FOV: 45 degrees. 2212x1659. Retinal fundus photograph:
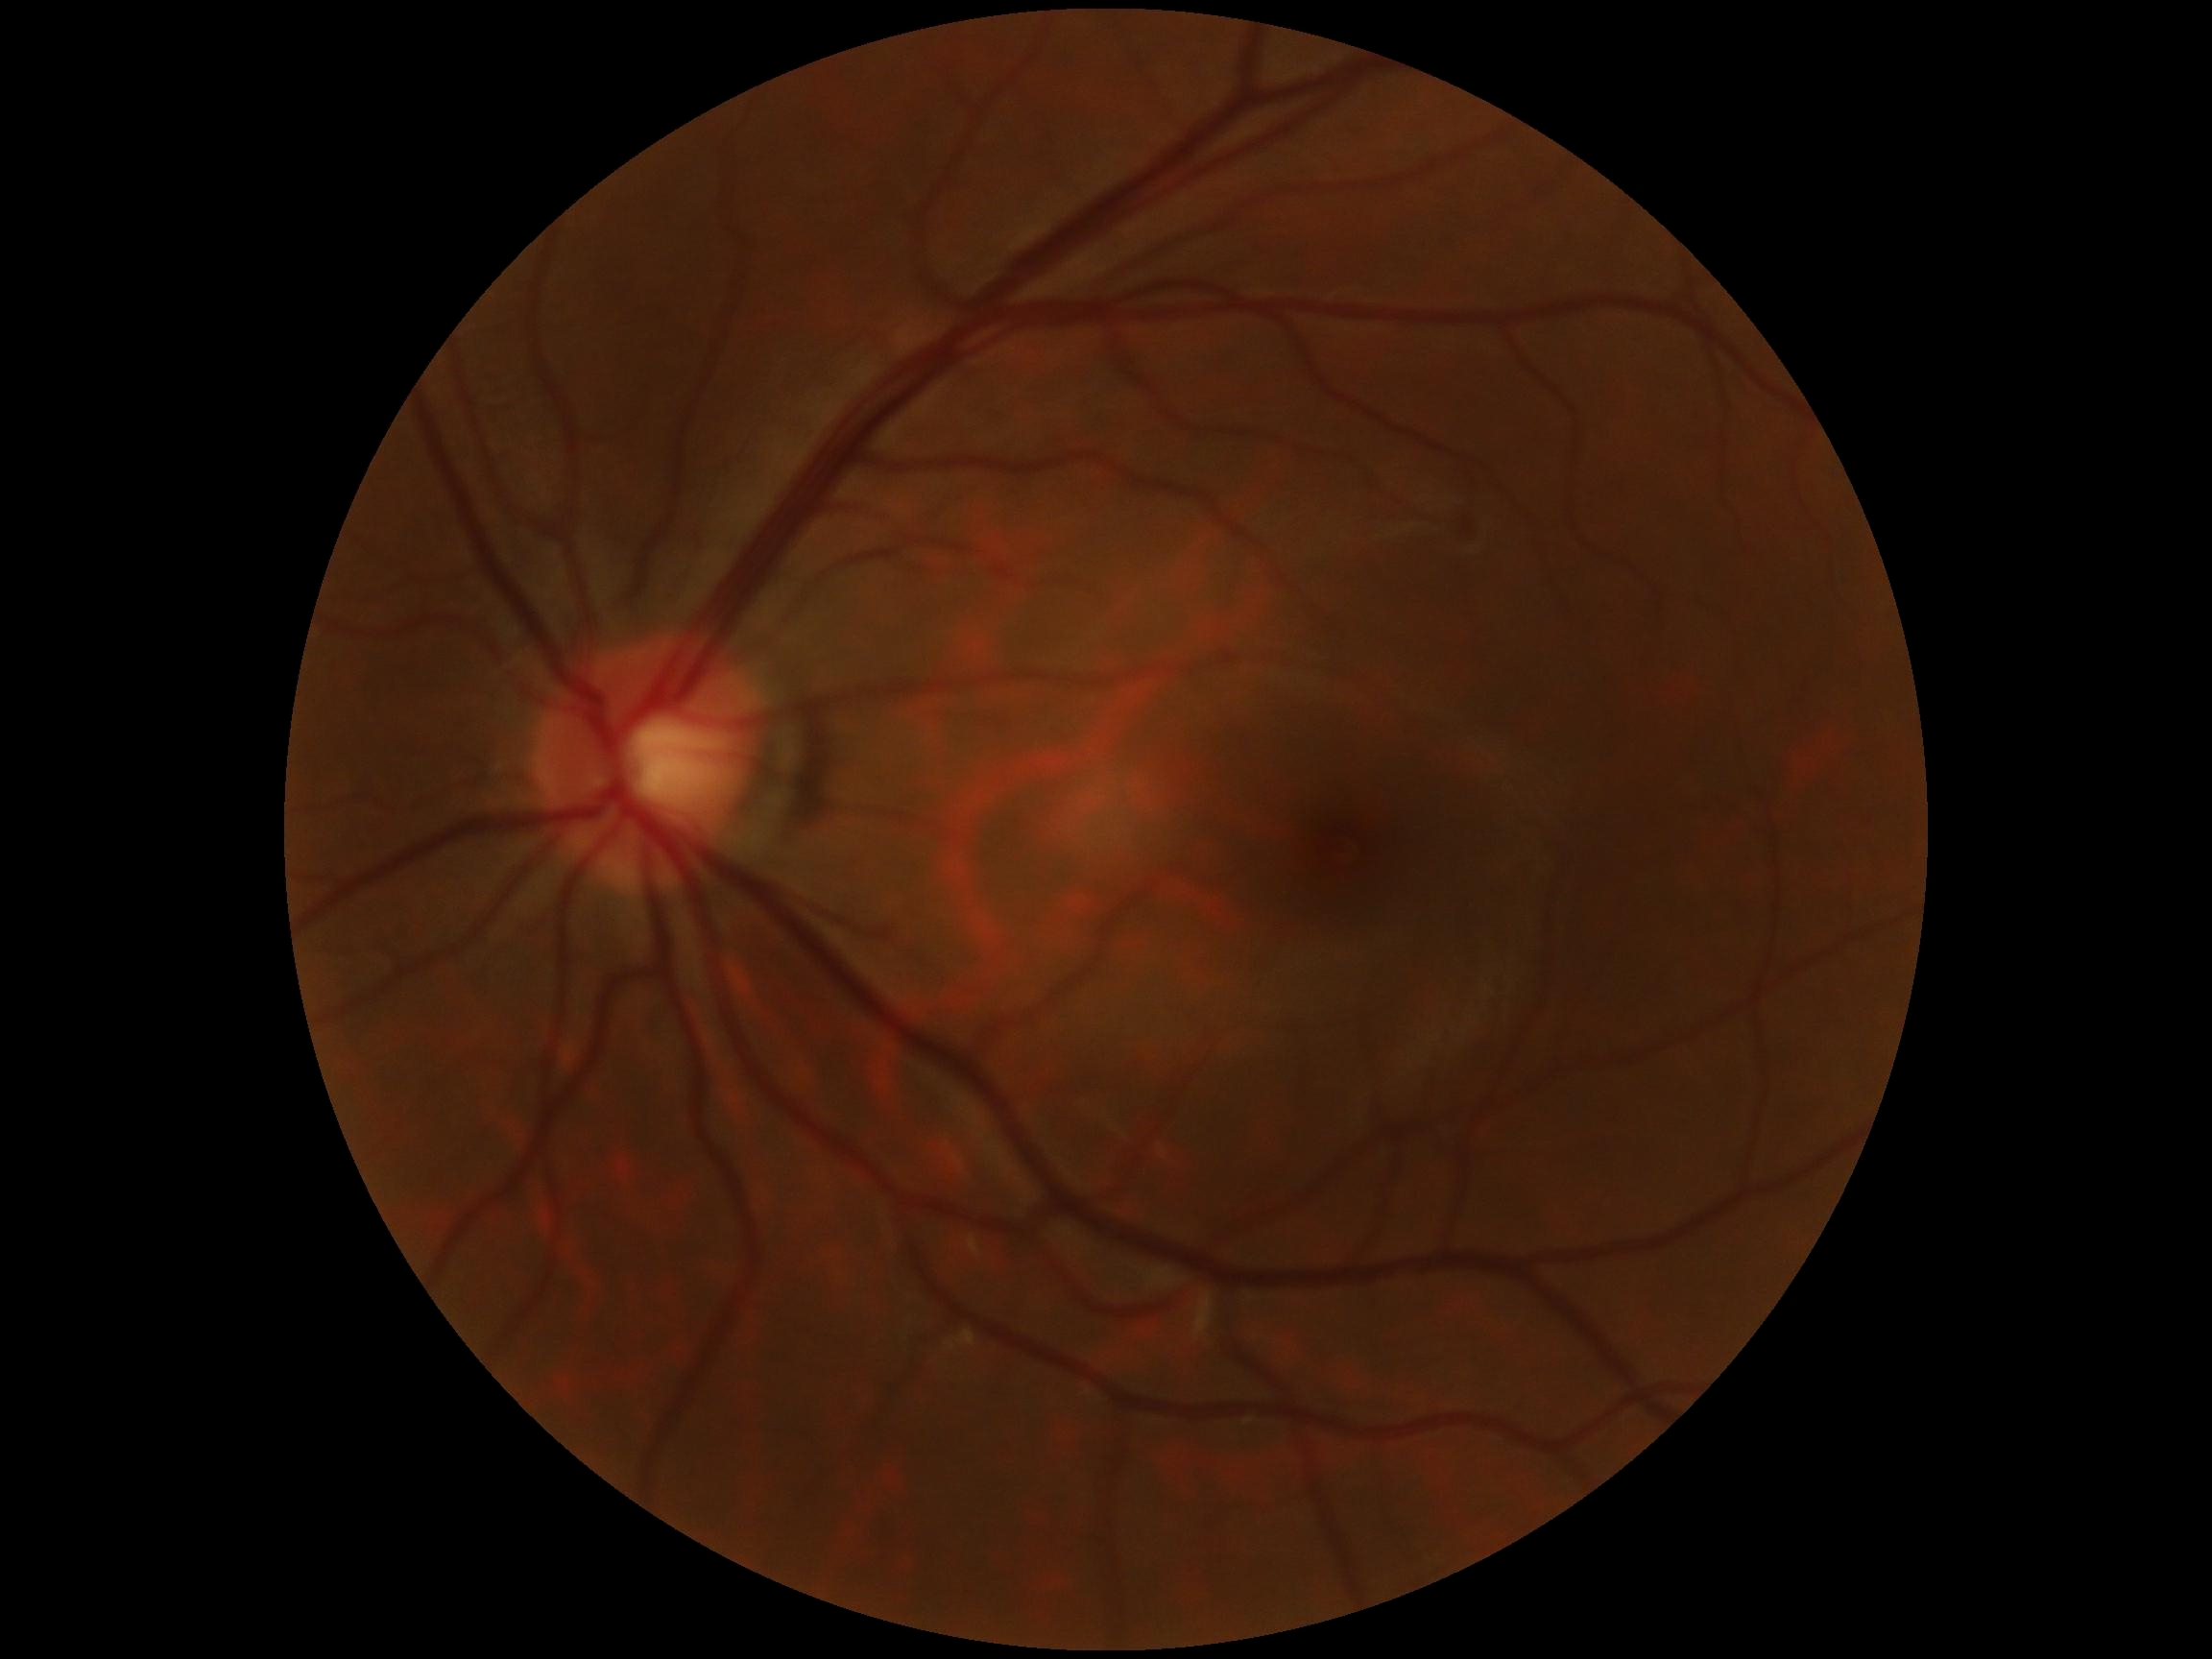

retinopathy grade: no apparent retinopathy (0).